Captured on a Nidek AFC-330 fundus camera · captured without pupil dilation.
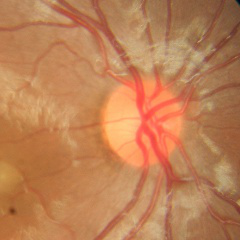 Fundus appearance consistent with no glaucomatous findings.